640x480; 130° field of view (Clarity RetCam 3); pediatric retinal photograph (wide-field): 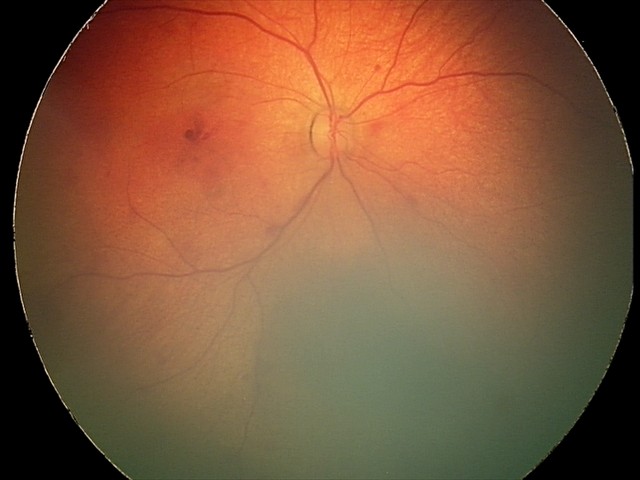
Series diagnosed as retinal hemorrhages.